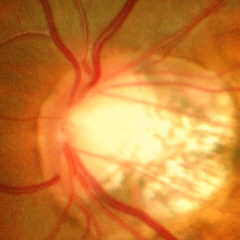

Q: What stage of glaucoma is present?
A: Yes — advanced glaucoma.